45° FOV
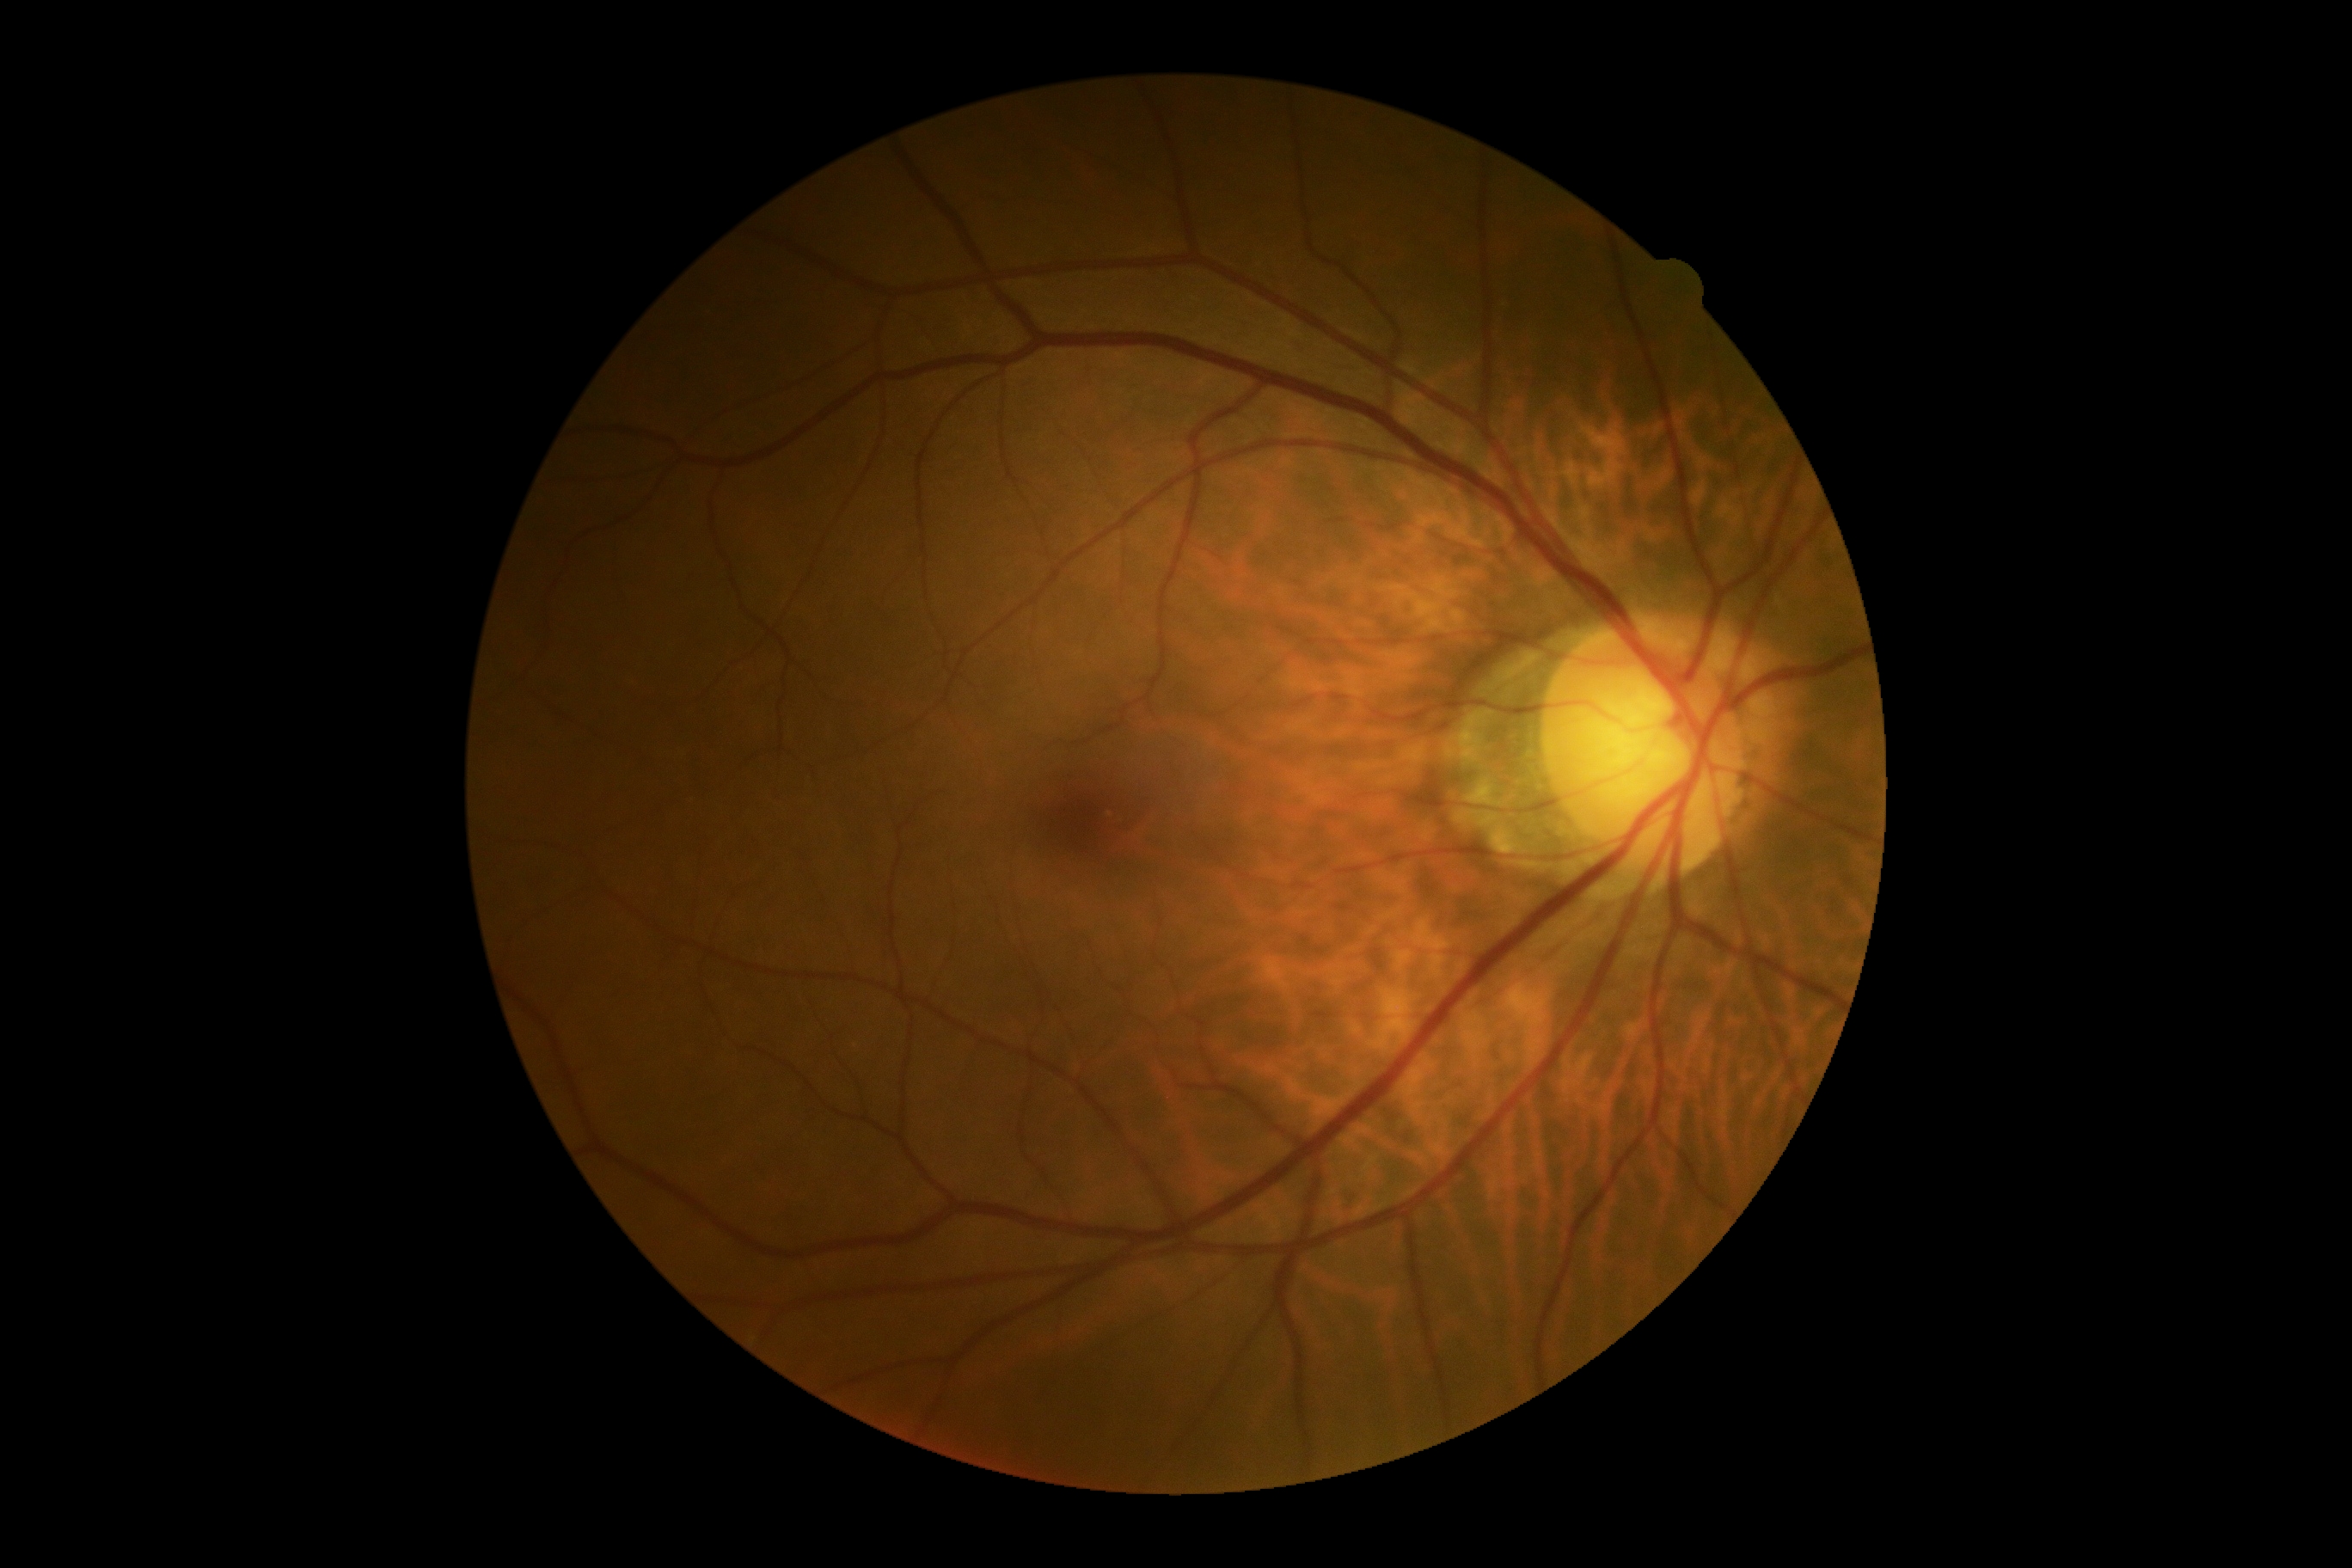 DR grade: no apparent retinopathy (0) — no visible signs of diabetic retinopathy.